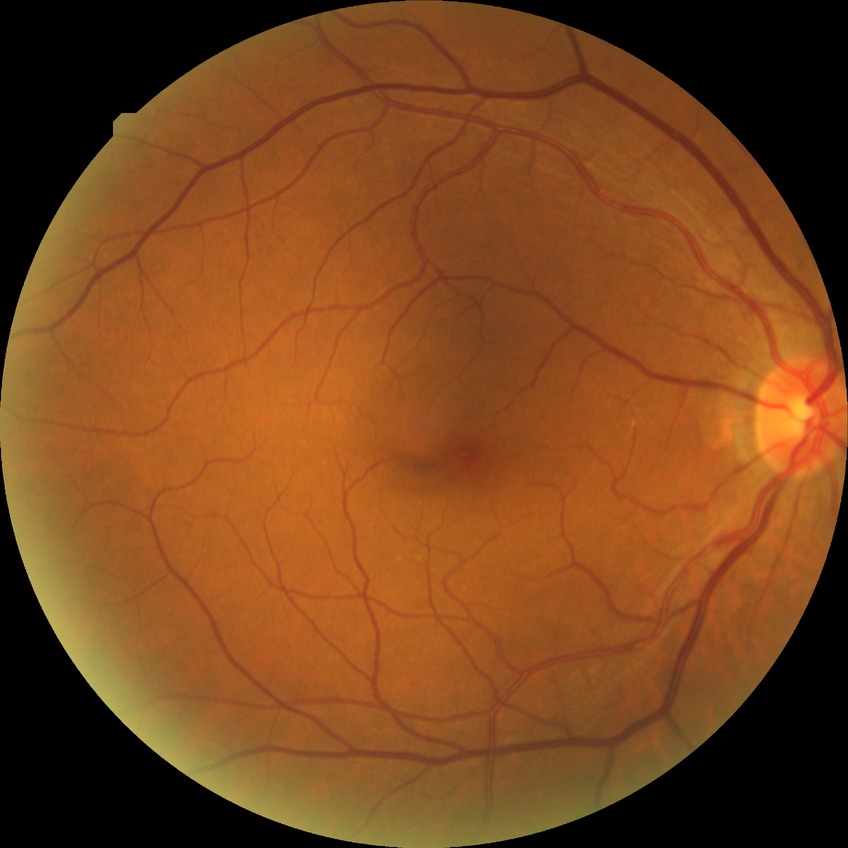
Diabetic retinopathy (DR) is no diabetic retinopathy (NDR).